Without pupil dilation, 45 degree fundus photograph, fundus photo, acquired with a NIDEK AFC-230
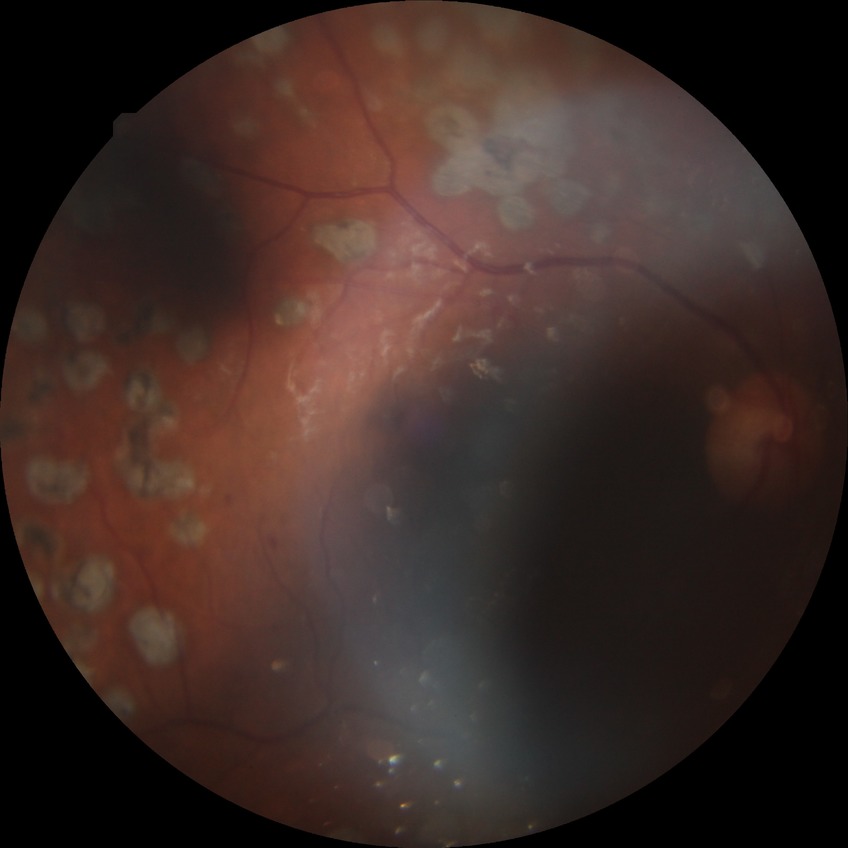
Diabetic retinopathy (DR): PDR (proliferative diabetic retinopathy).